848 x 848 pixels · color fundus photograph · camera: NIDEK AFC-230 · 45 degree fundus photograph:
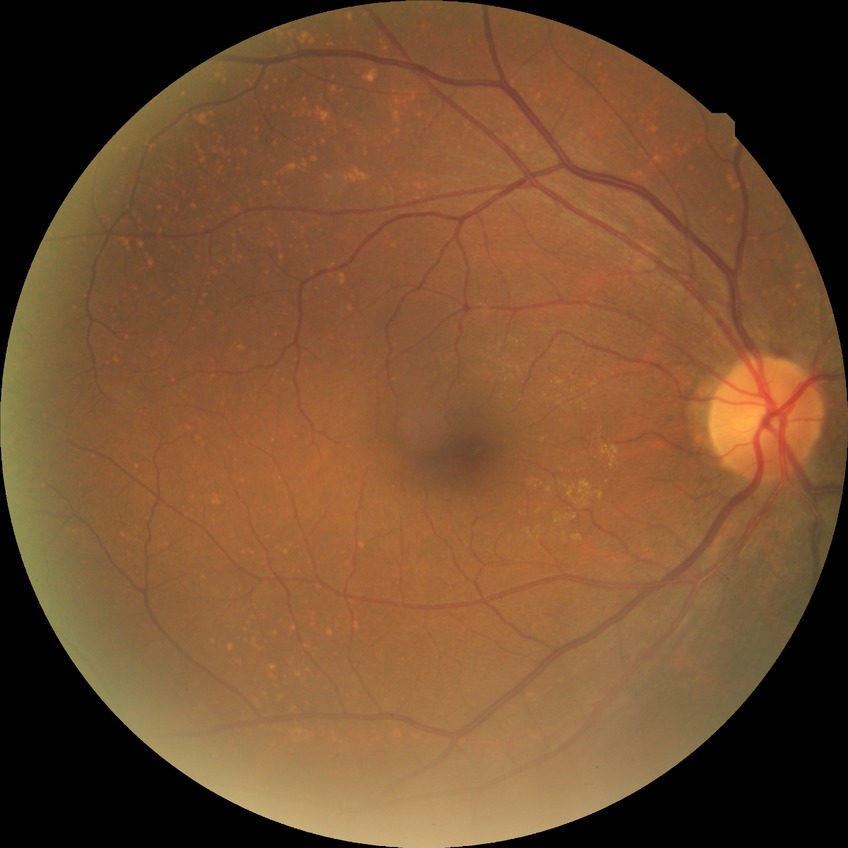
Davis grade = NDR, DR impression = negative for DR.